130° field of view (Clarity RetCam 3); 640x480; infant wide-field fundus photograph.
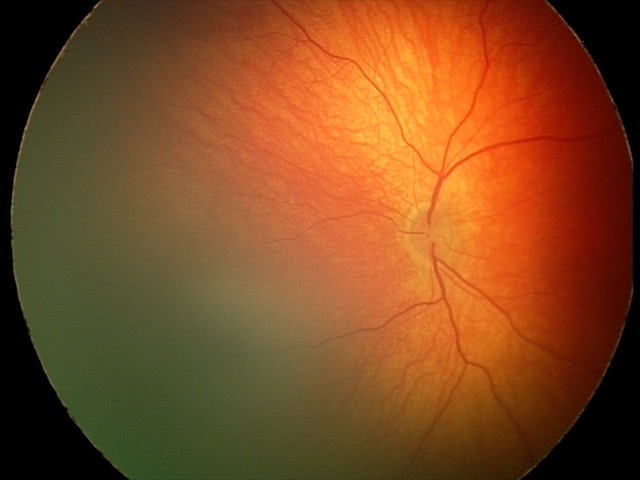
Examination diagnosed as retinal hemorrhages.